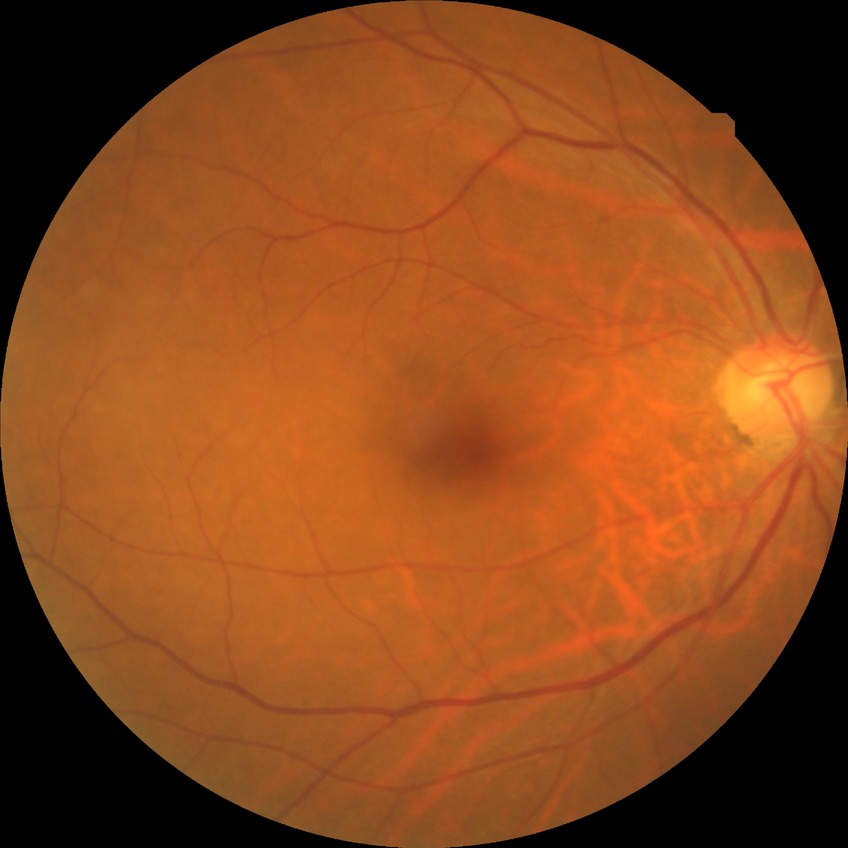

diabetic retinopathy (DR): NDR (no diabetic retinopathy).